Diabetic retinopathy graded by the modified Davis classification.
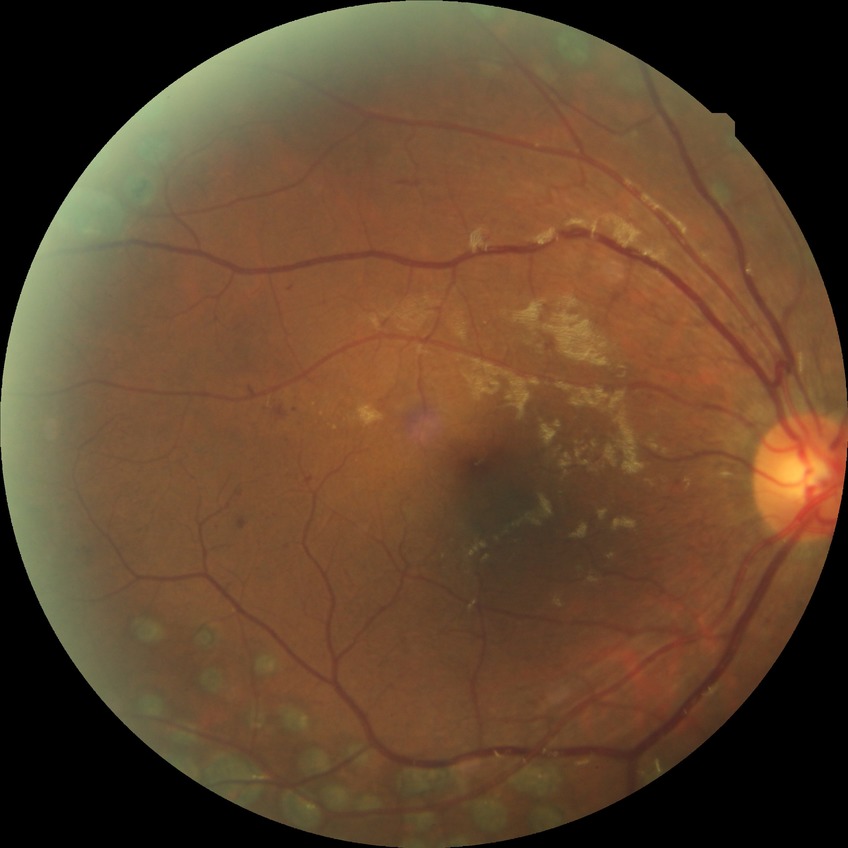

{
  "davis_grade": "proliferative diabetic retinopathy"
}